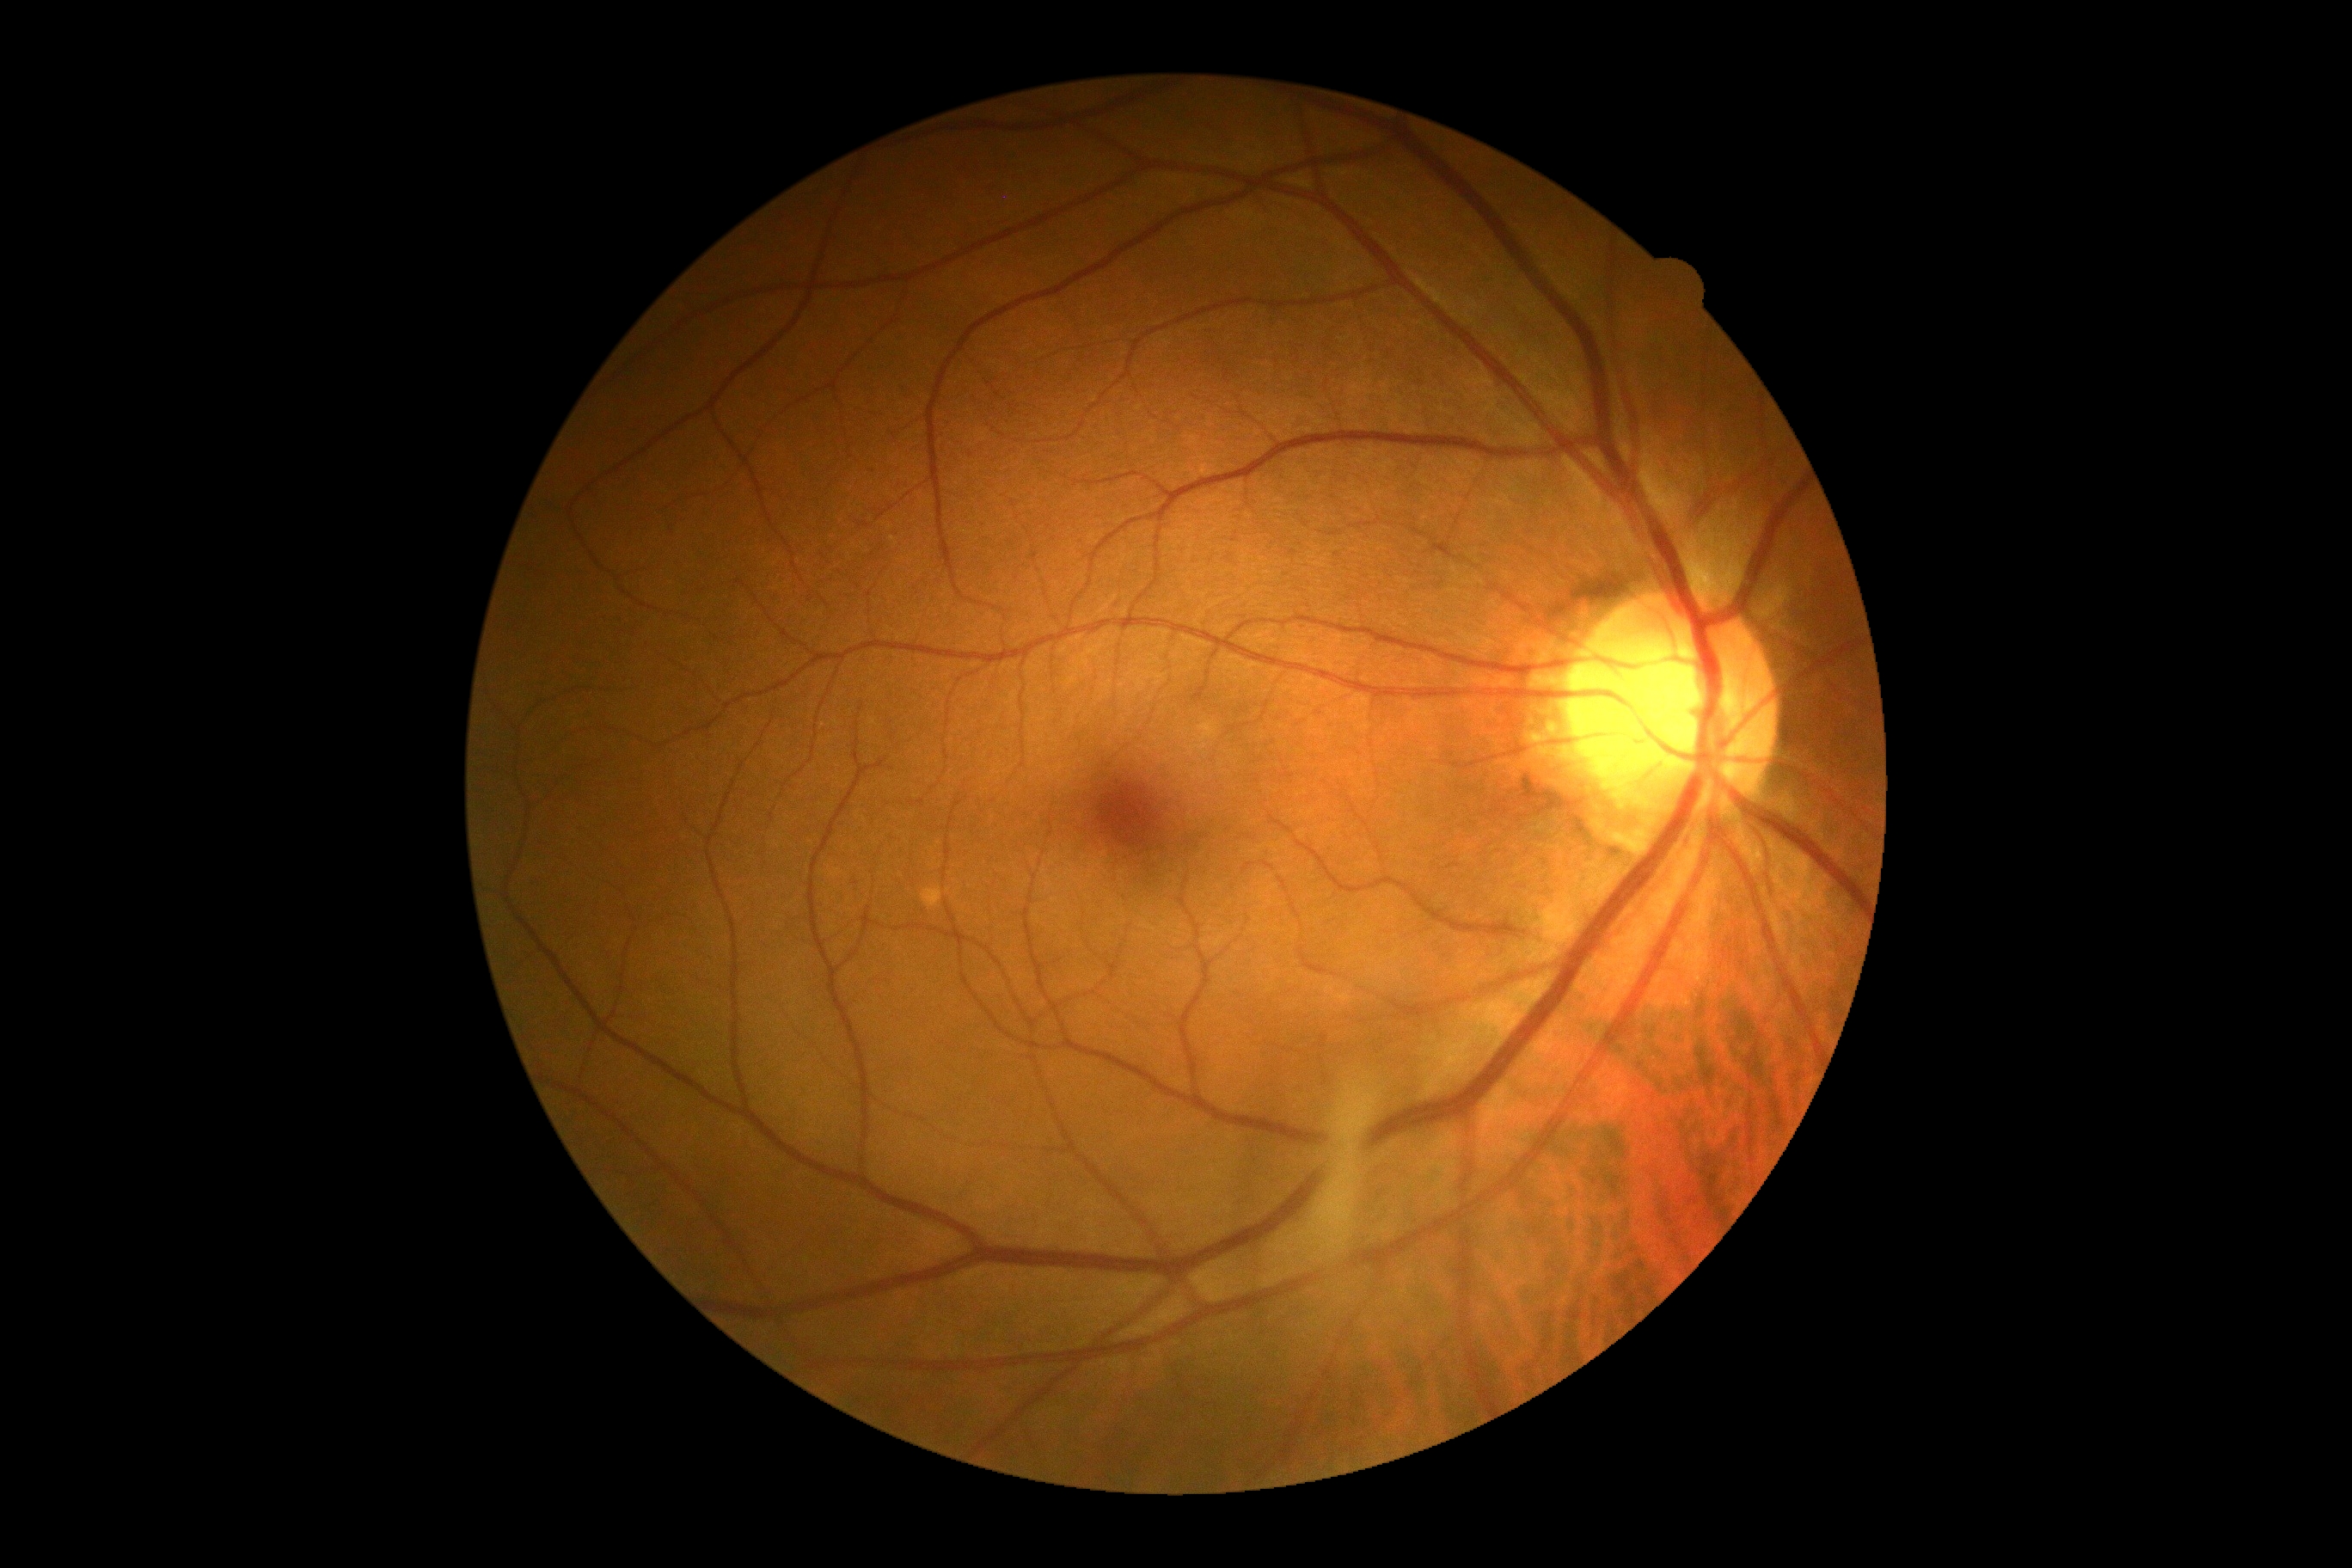 DR grade is 0.